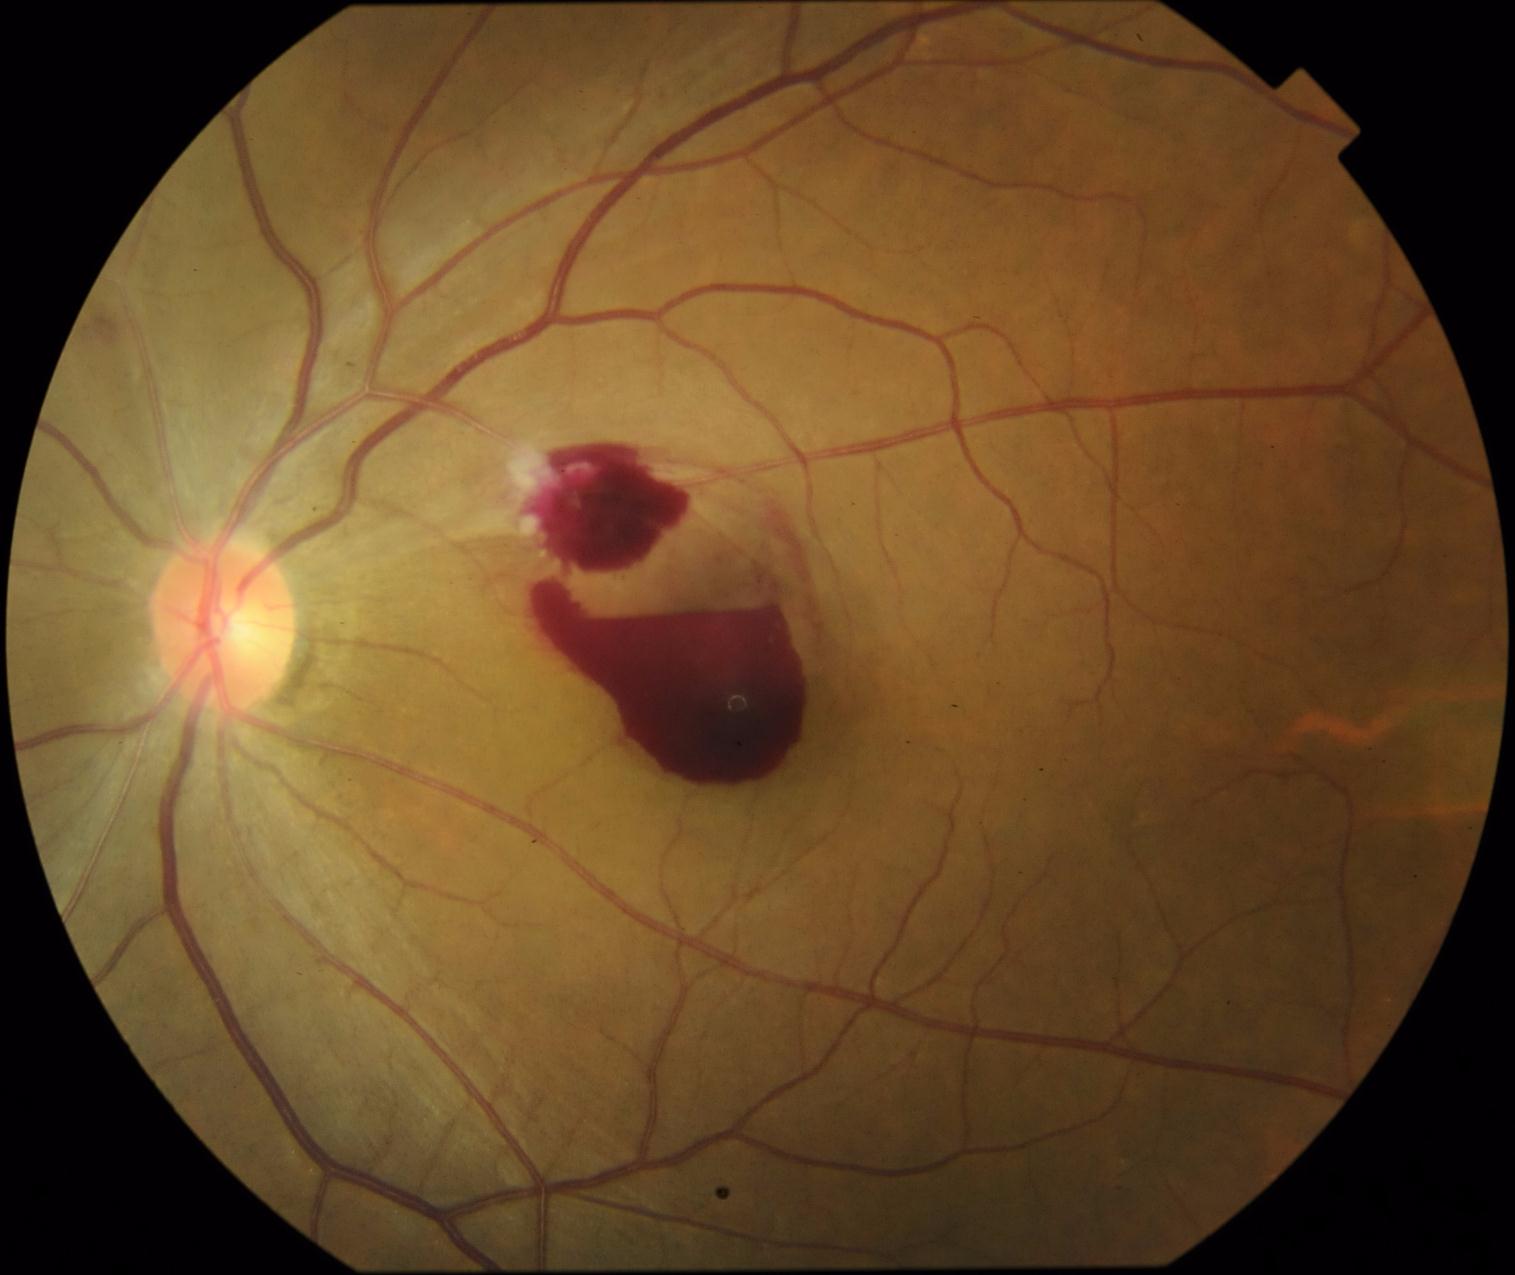 Retinopathy: 4/4.